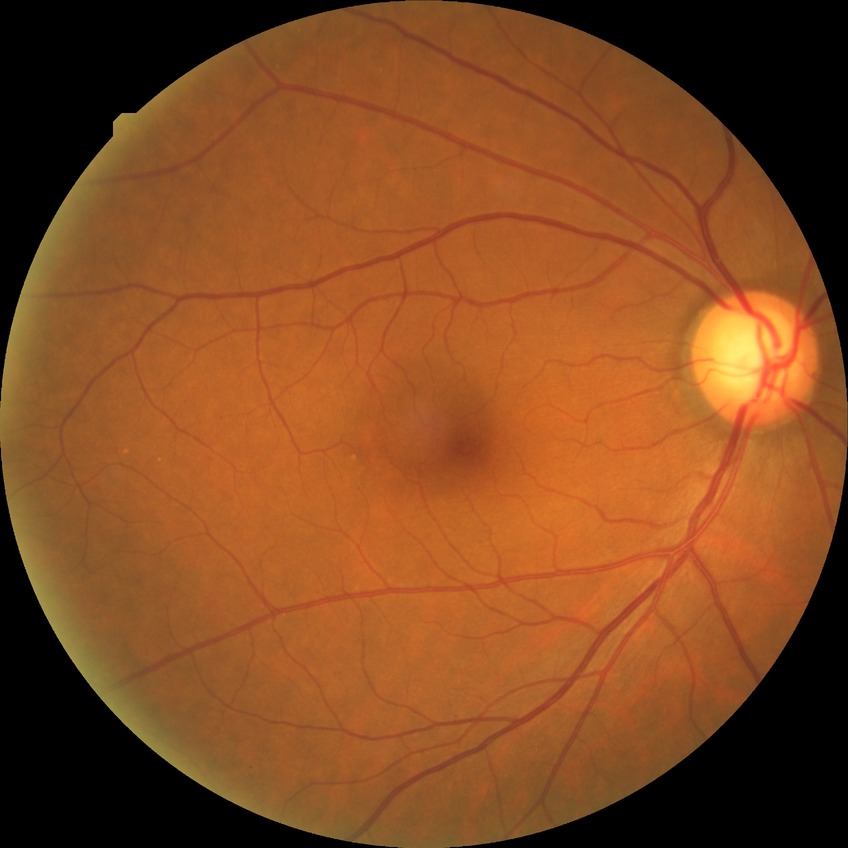
DR impression = no apparent DR, Davis DR grade = NDR.